Nonmydriatic fundus photograph. Color fundus image. Diabetic retinopathy graded by the modified Davis classification.
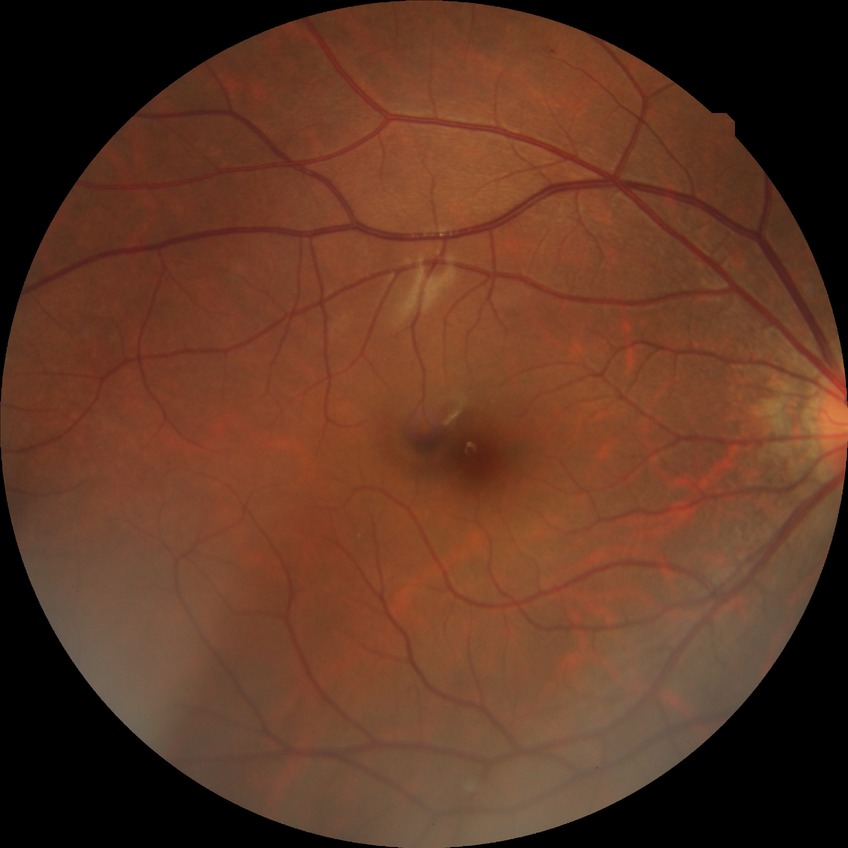
diabetic retinopathy (DR) = NDR (no diabetic retinopathy).